FOV: 45 degrees
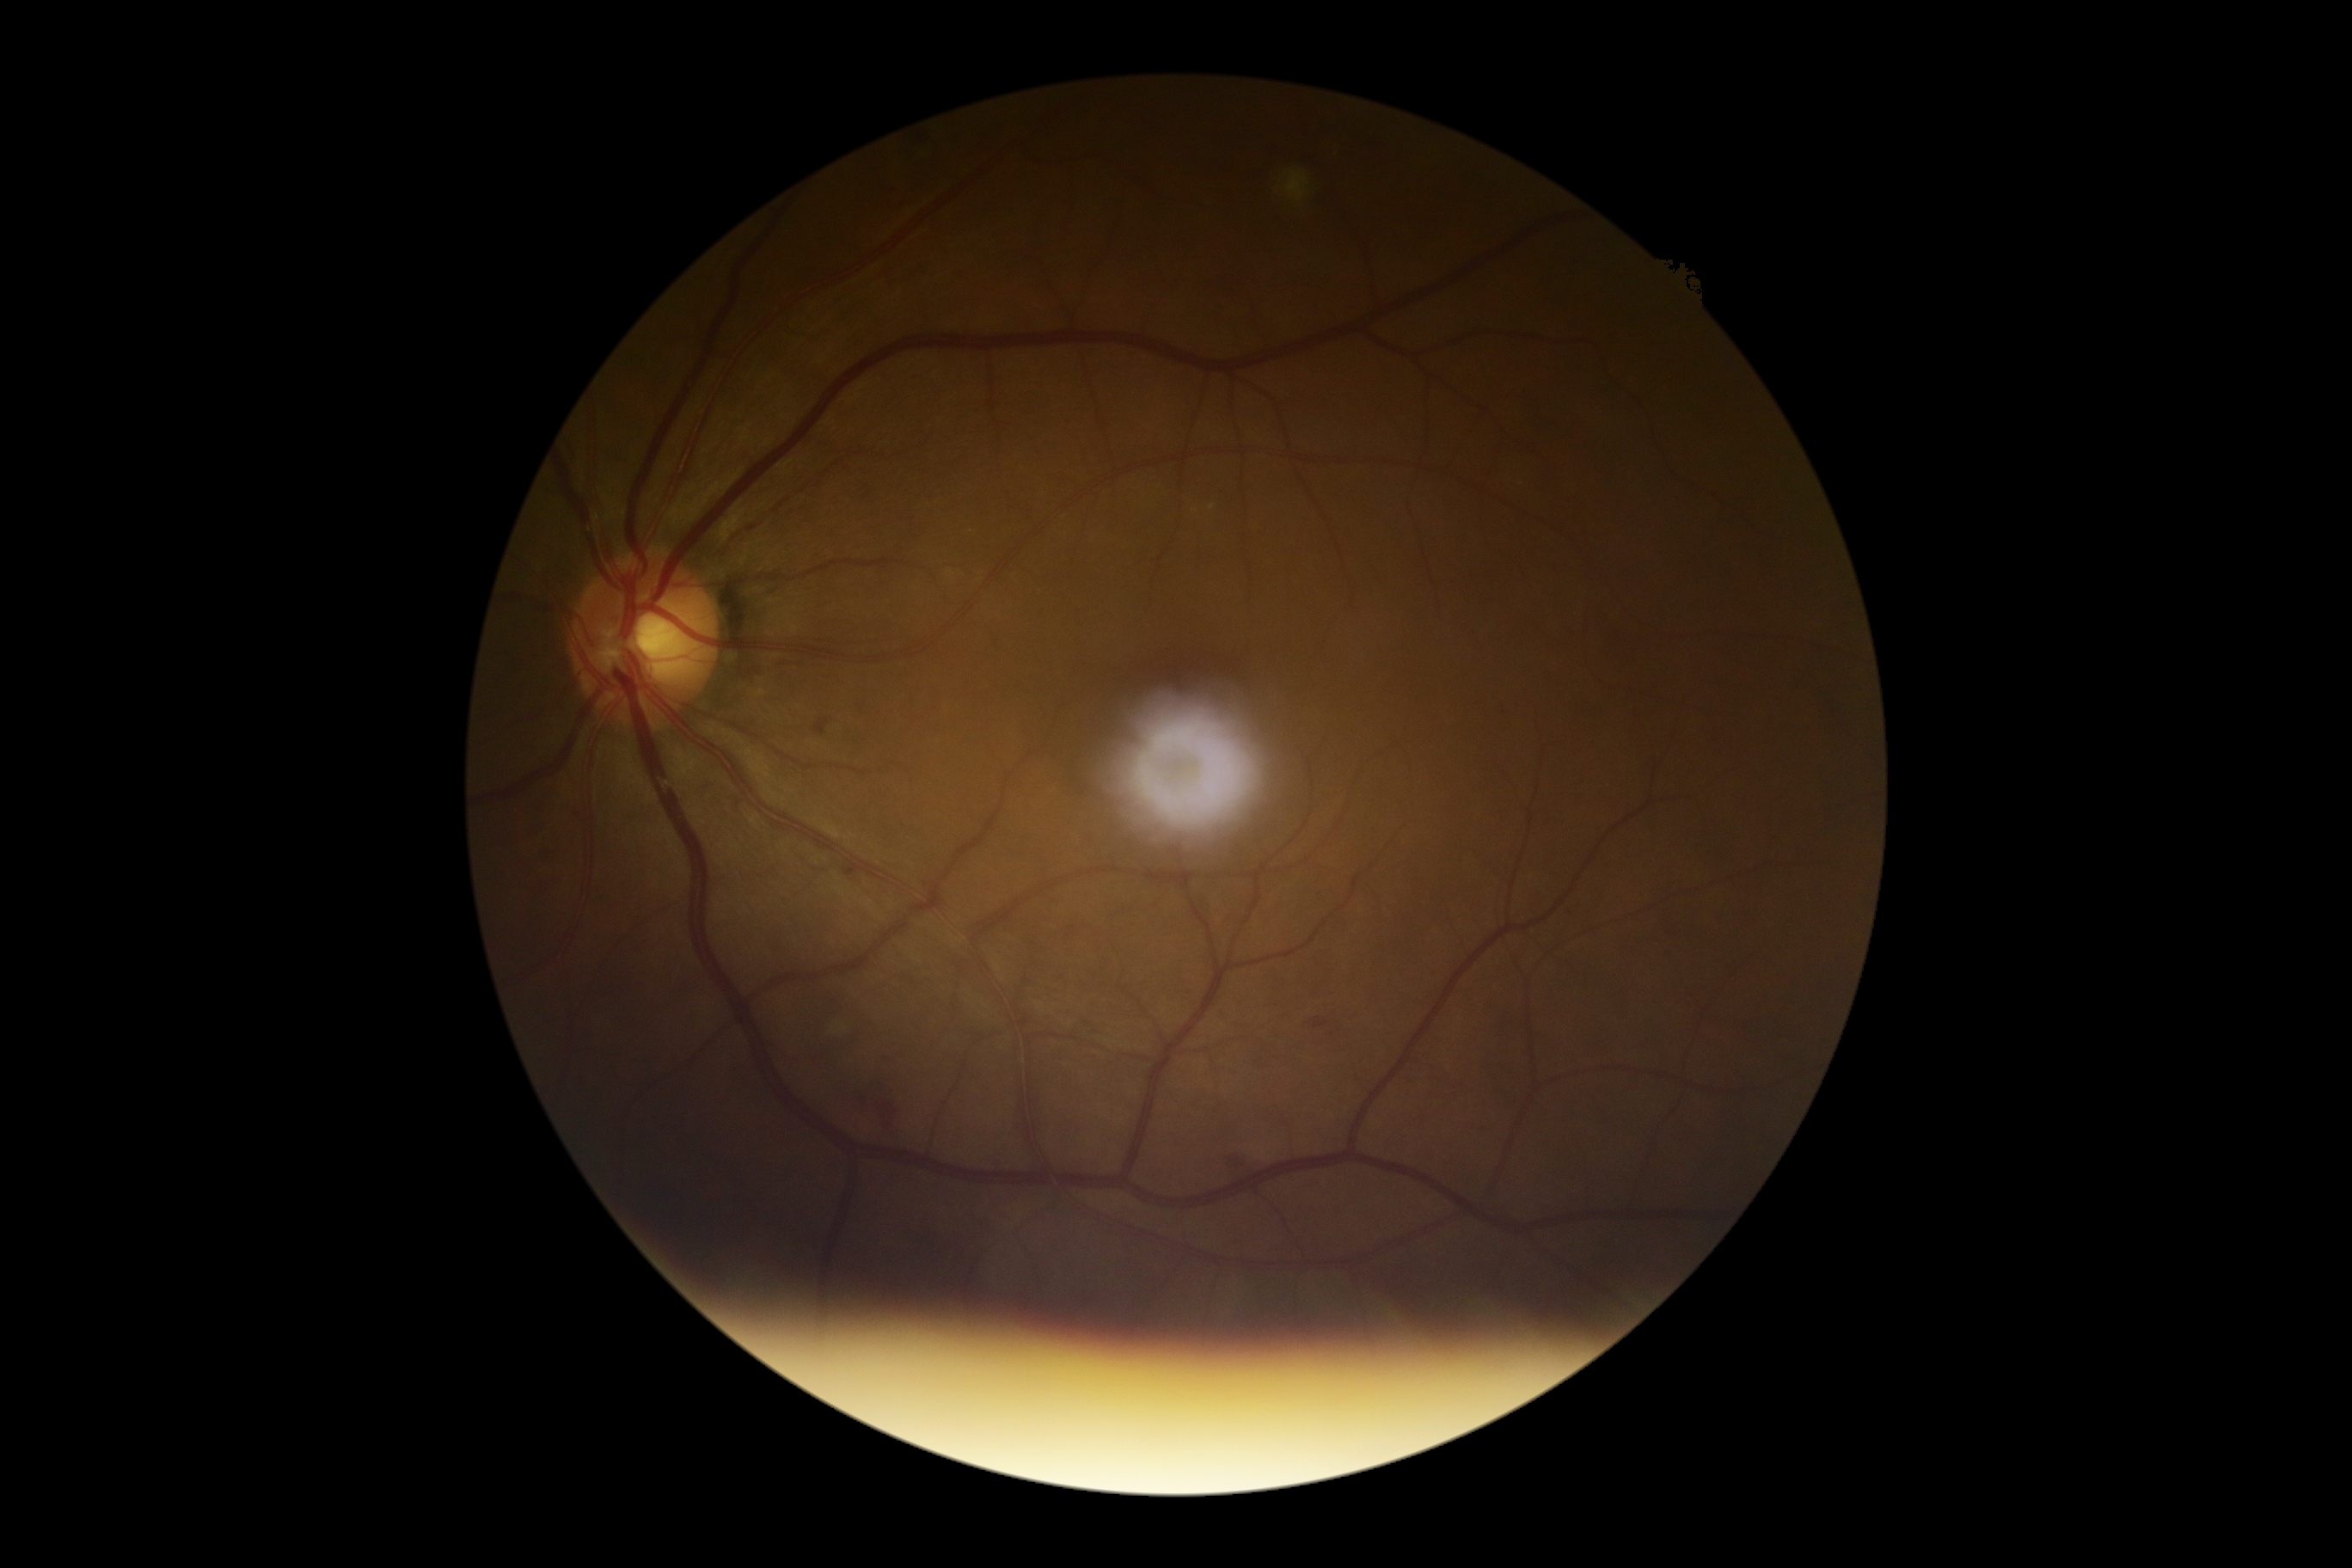

The retinopathy is classified as non-proliferative diabetic retinopathy.
Diabetic retinopathy: 2 — more than just microaneurysms but less than severe NPDR.